Fundus photo:
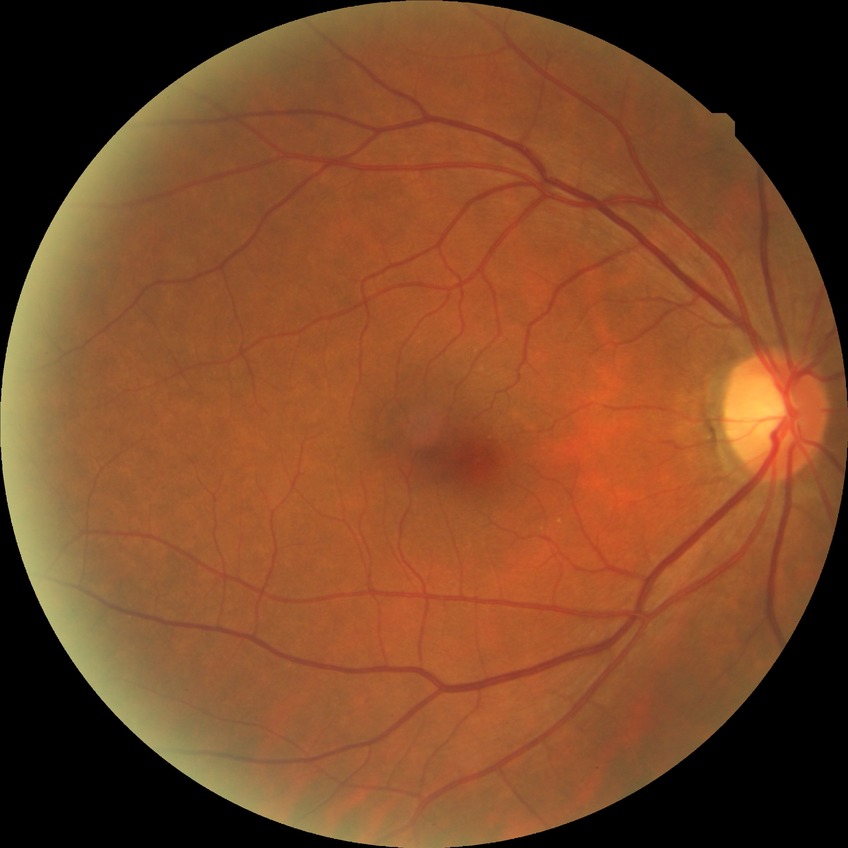 modified Davis classification: no diabetic retinopathy.